CFP: 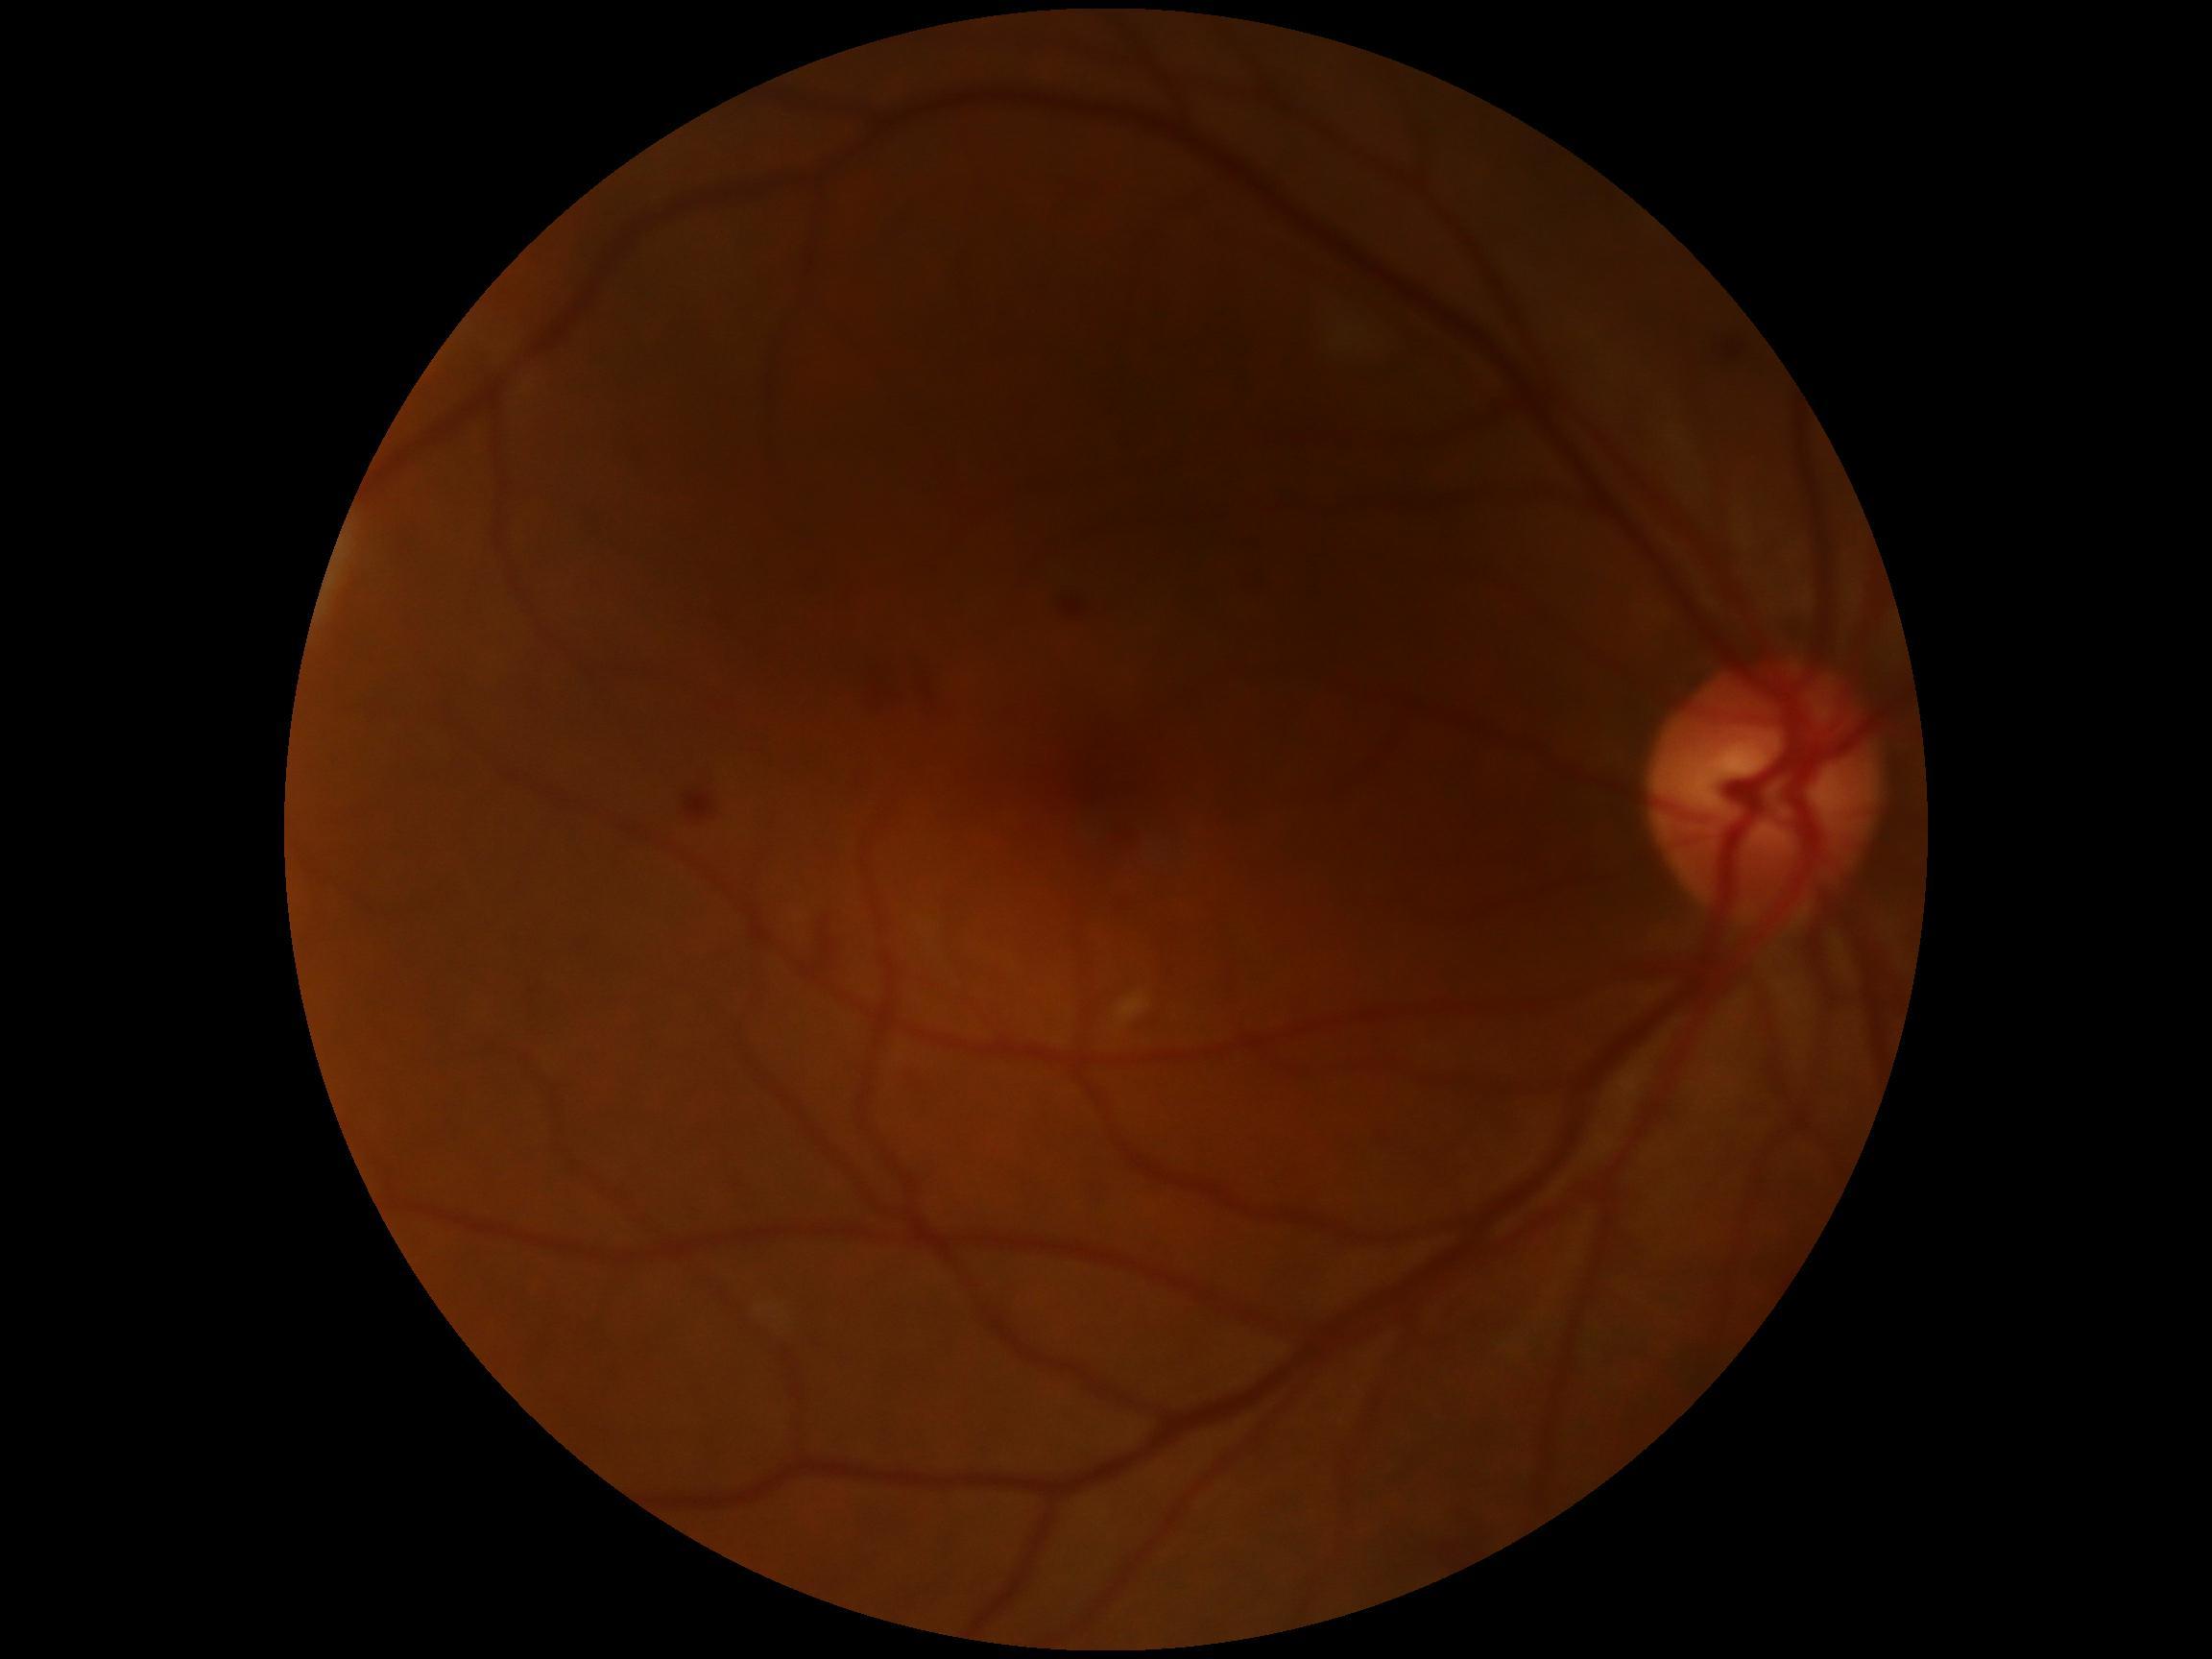 DR grade is moderate non-proliferative diabetic retinopathy (2). Disease class: non-proliferative diabetic retinopathy.